Captured with the Clarity RetCam 3 (130° field of view). 640x480px. Infant wide-field fundus photograph — 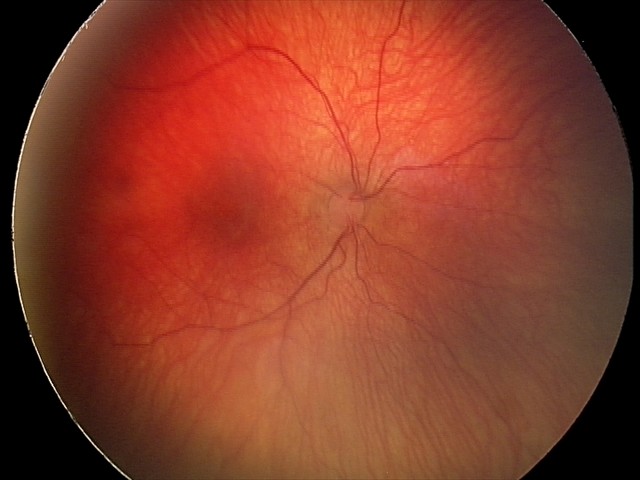
Examination diagnosed as status post retinopathy of prematurity (ROP) — retinal appearance after treated retinopathy of prematurity.
No plus disease.